Modified Davis classification — 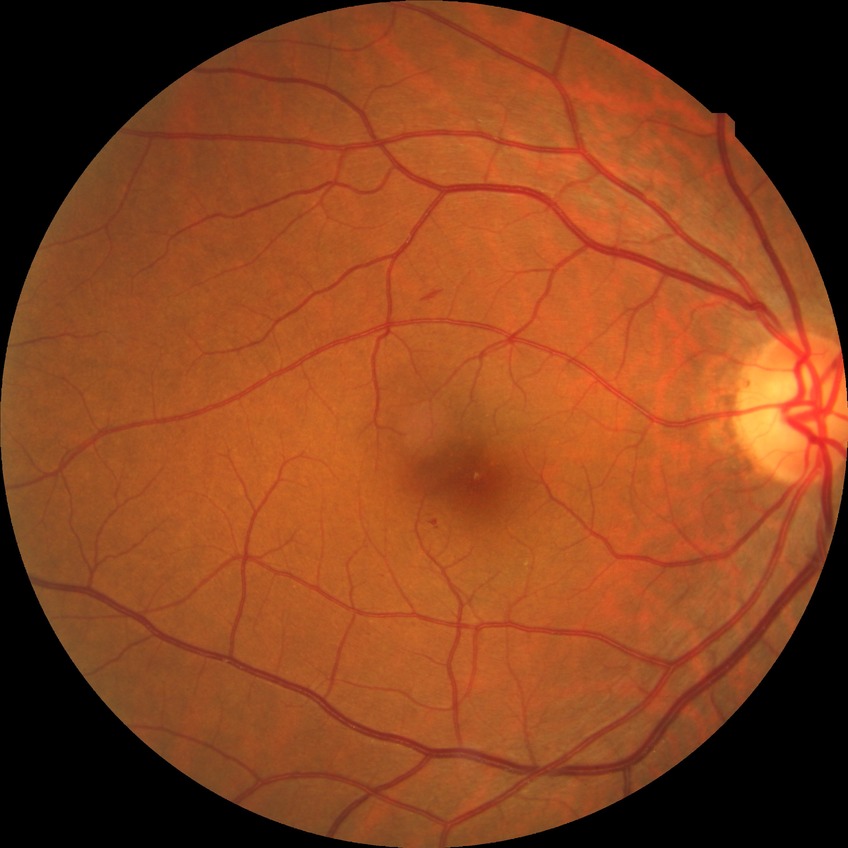
davis_grade: SDR